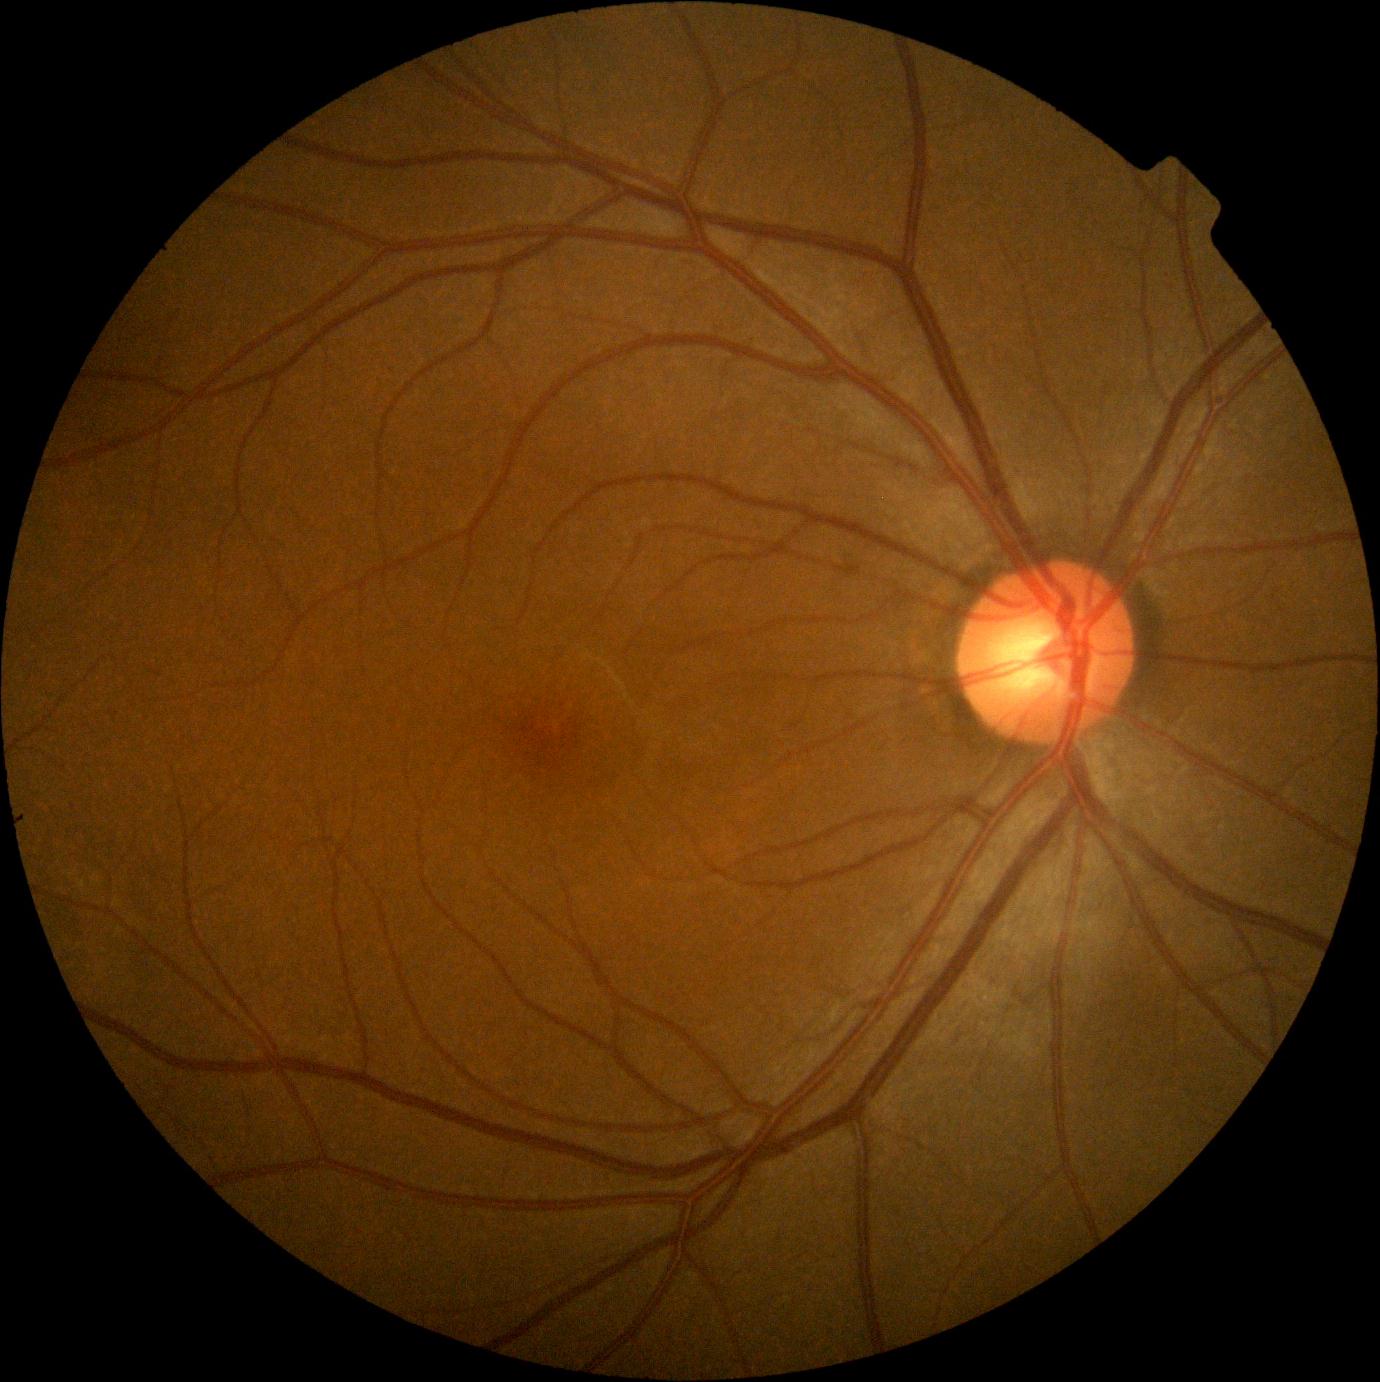 Annotations:
– DR impression: no signs of DR
– diabetic retinopathy (DR): no apparent diabetic retinopathy (grade 0)